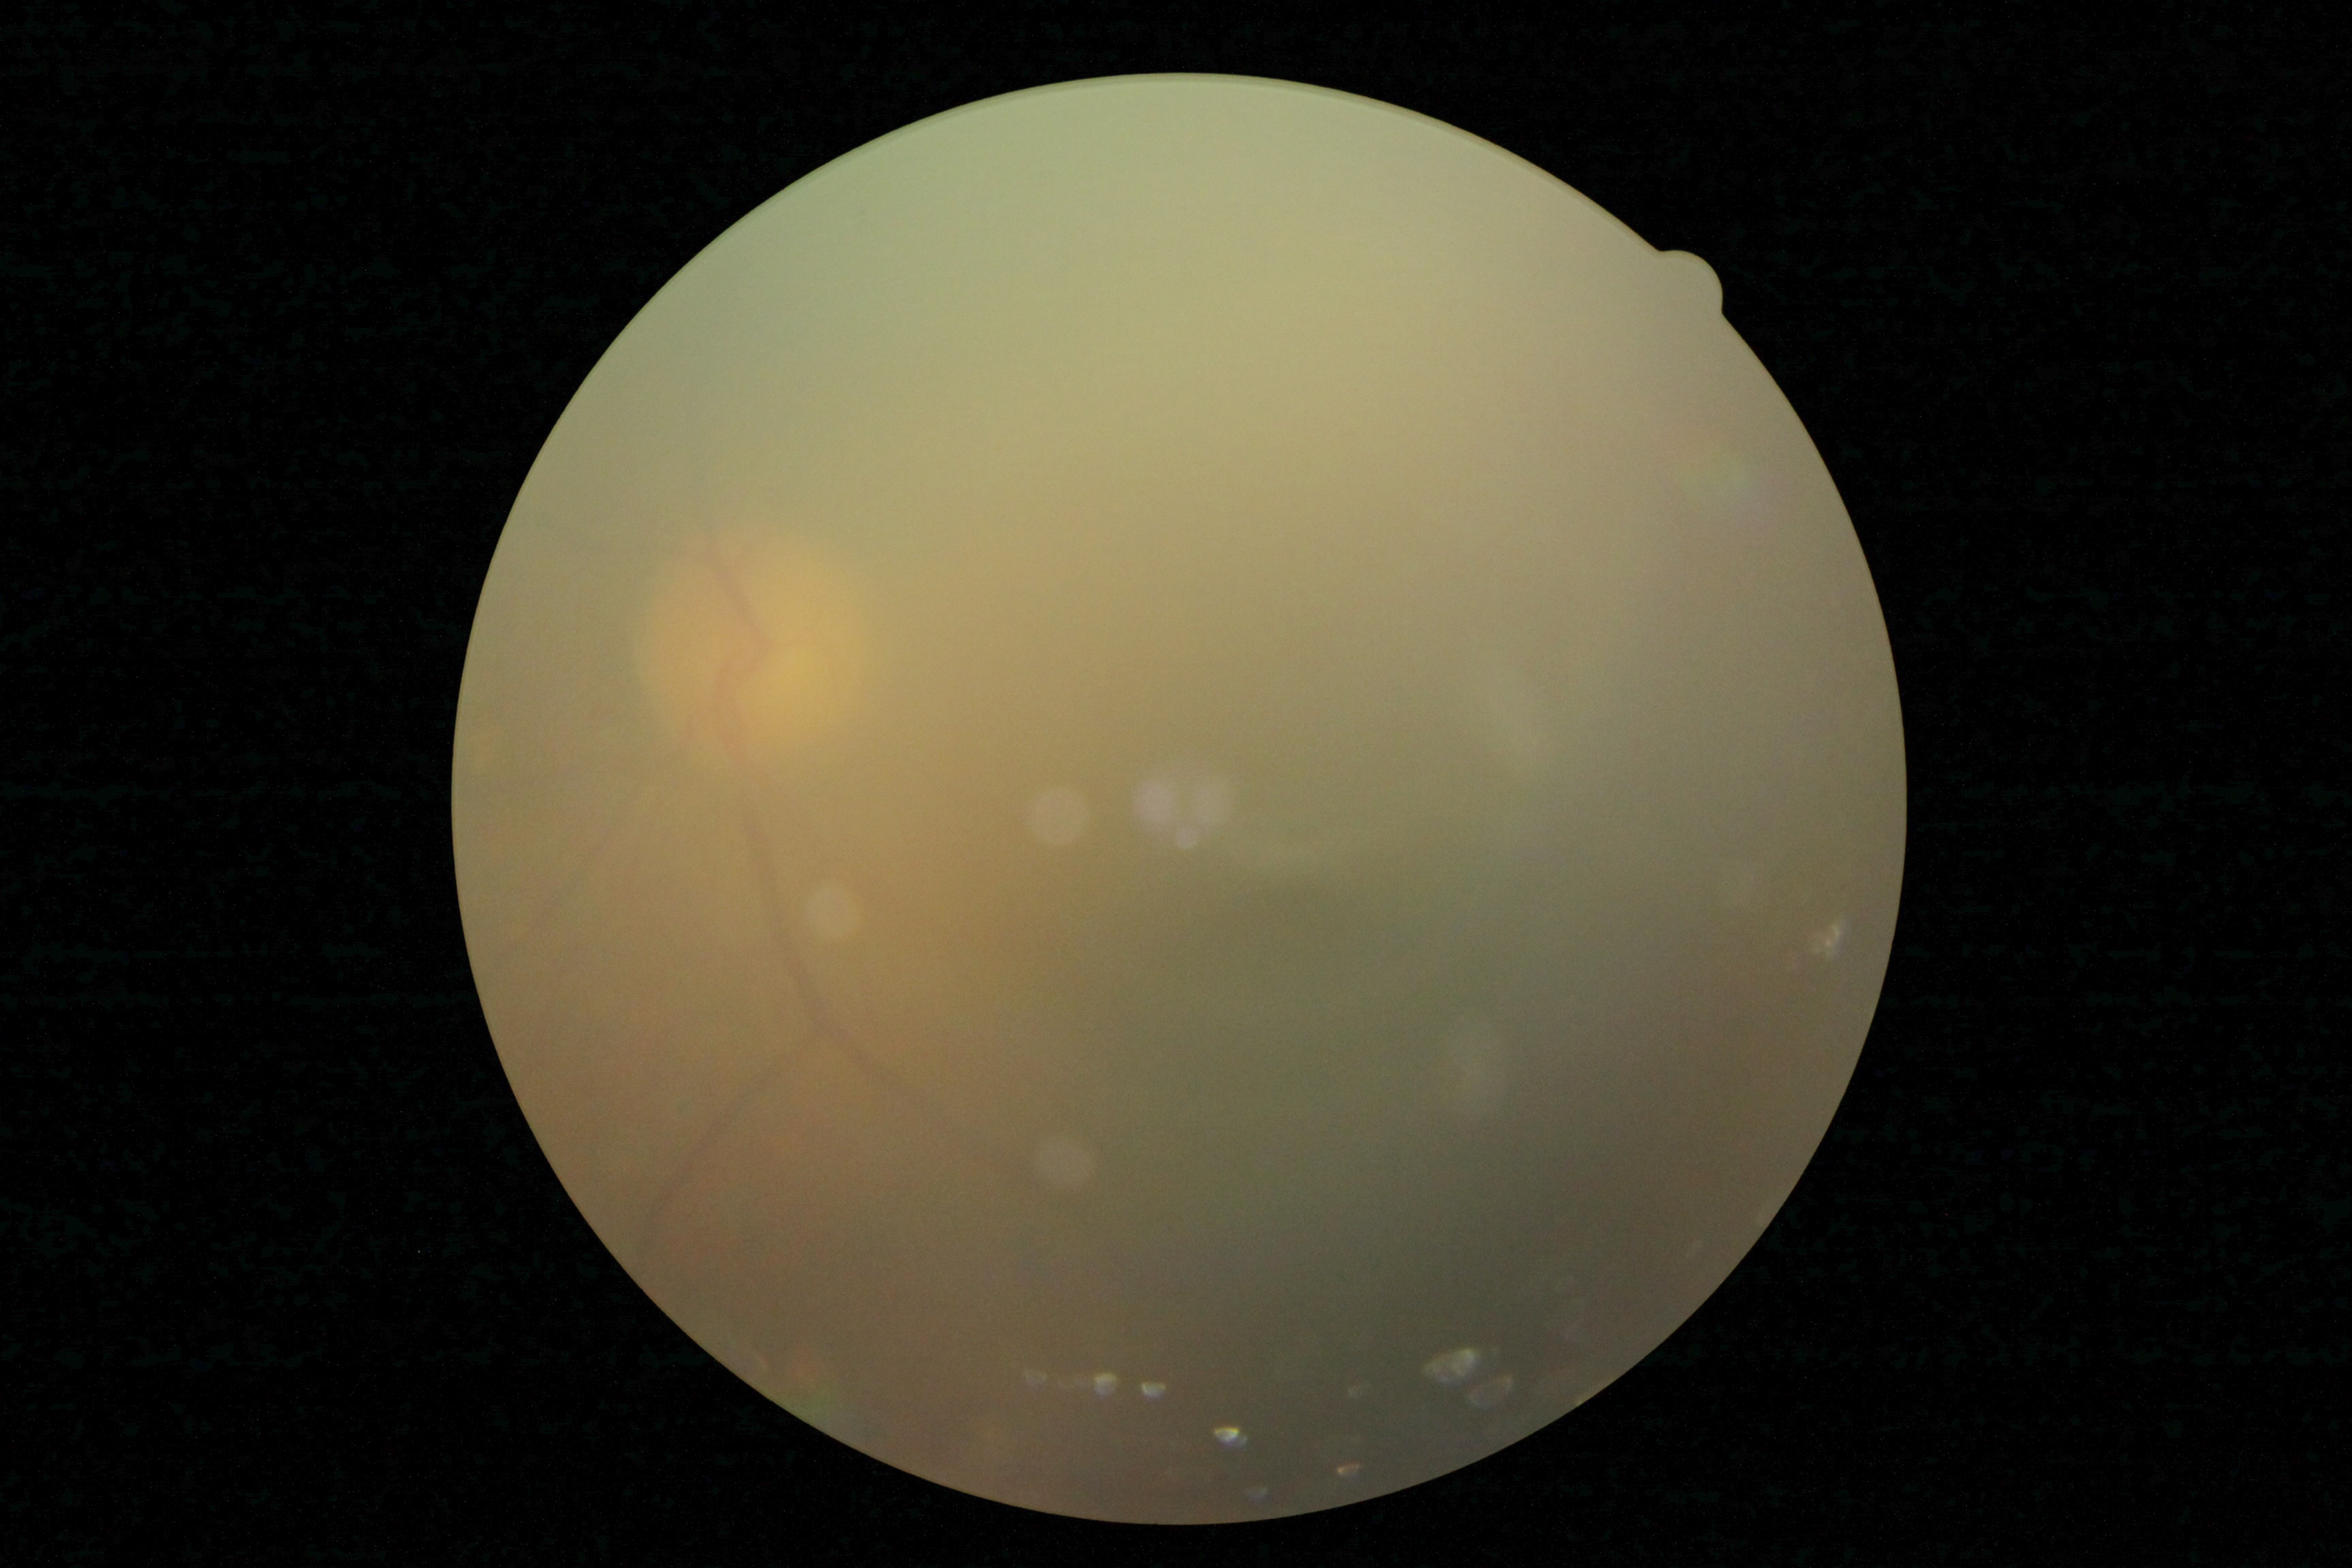 Diabetic retinopathy grade is ungradable.
Ungradable image — DR severity cannot be determined.